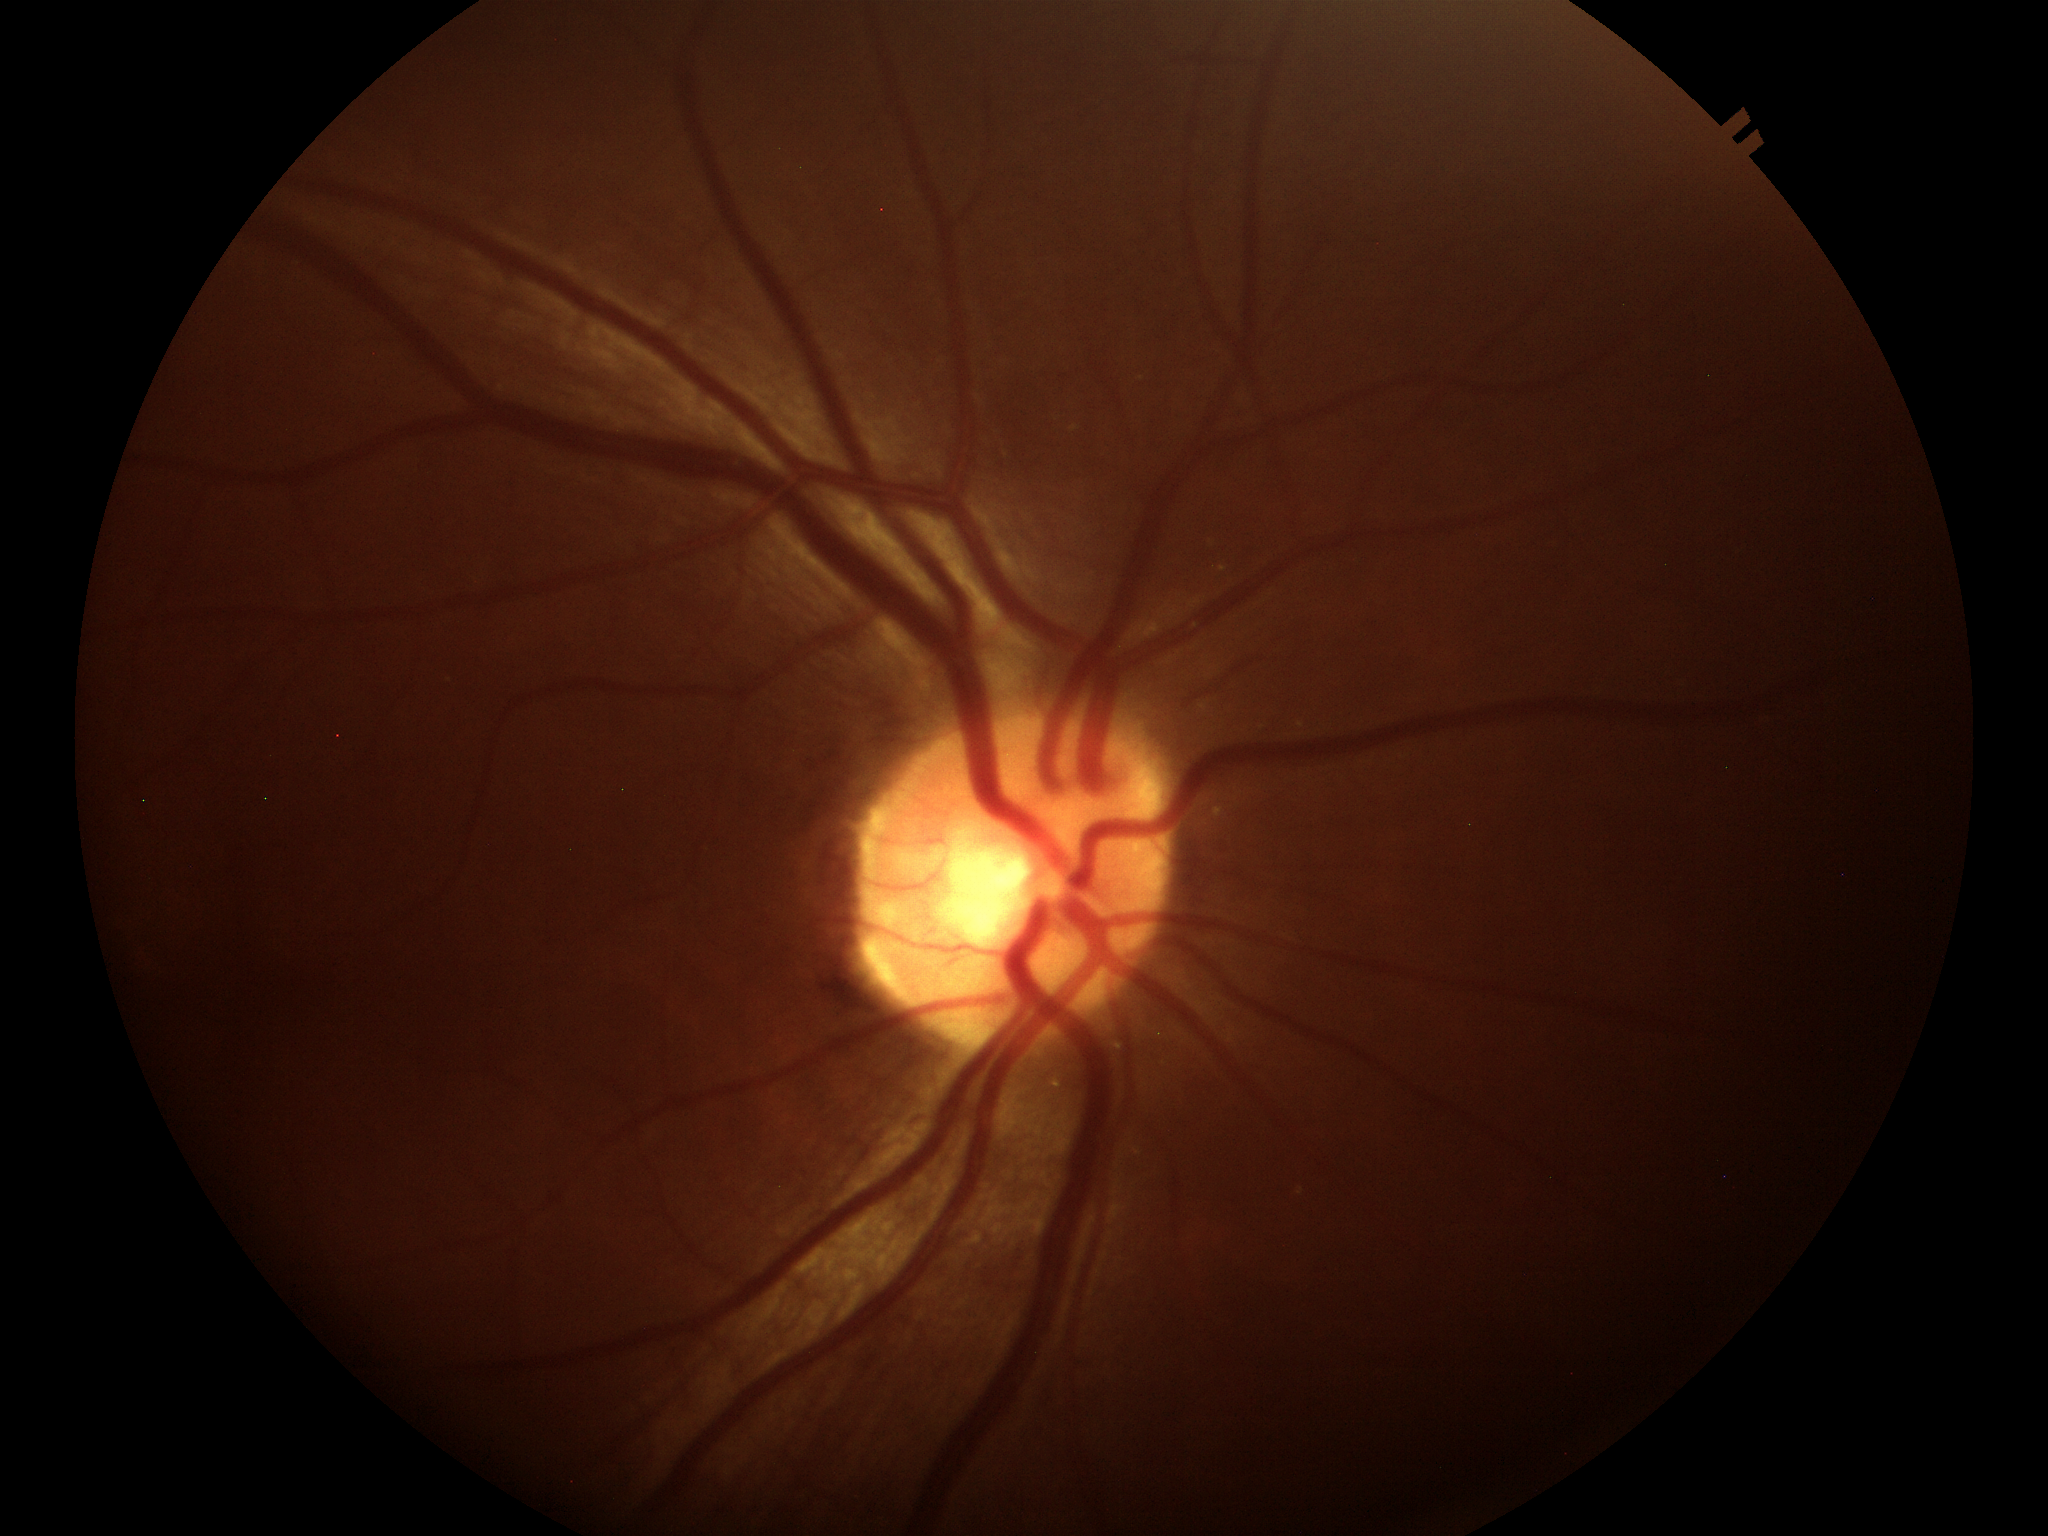 Vertical cup-disc ratio (VCDR) is 0.51. Glaucoma evaluation: negative.